45° FOV
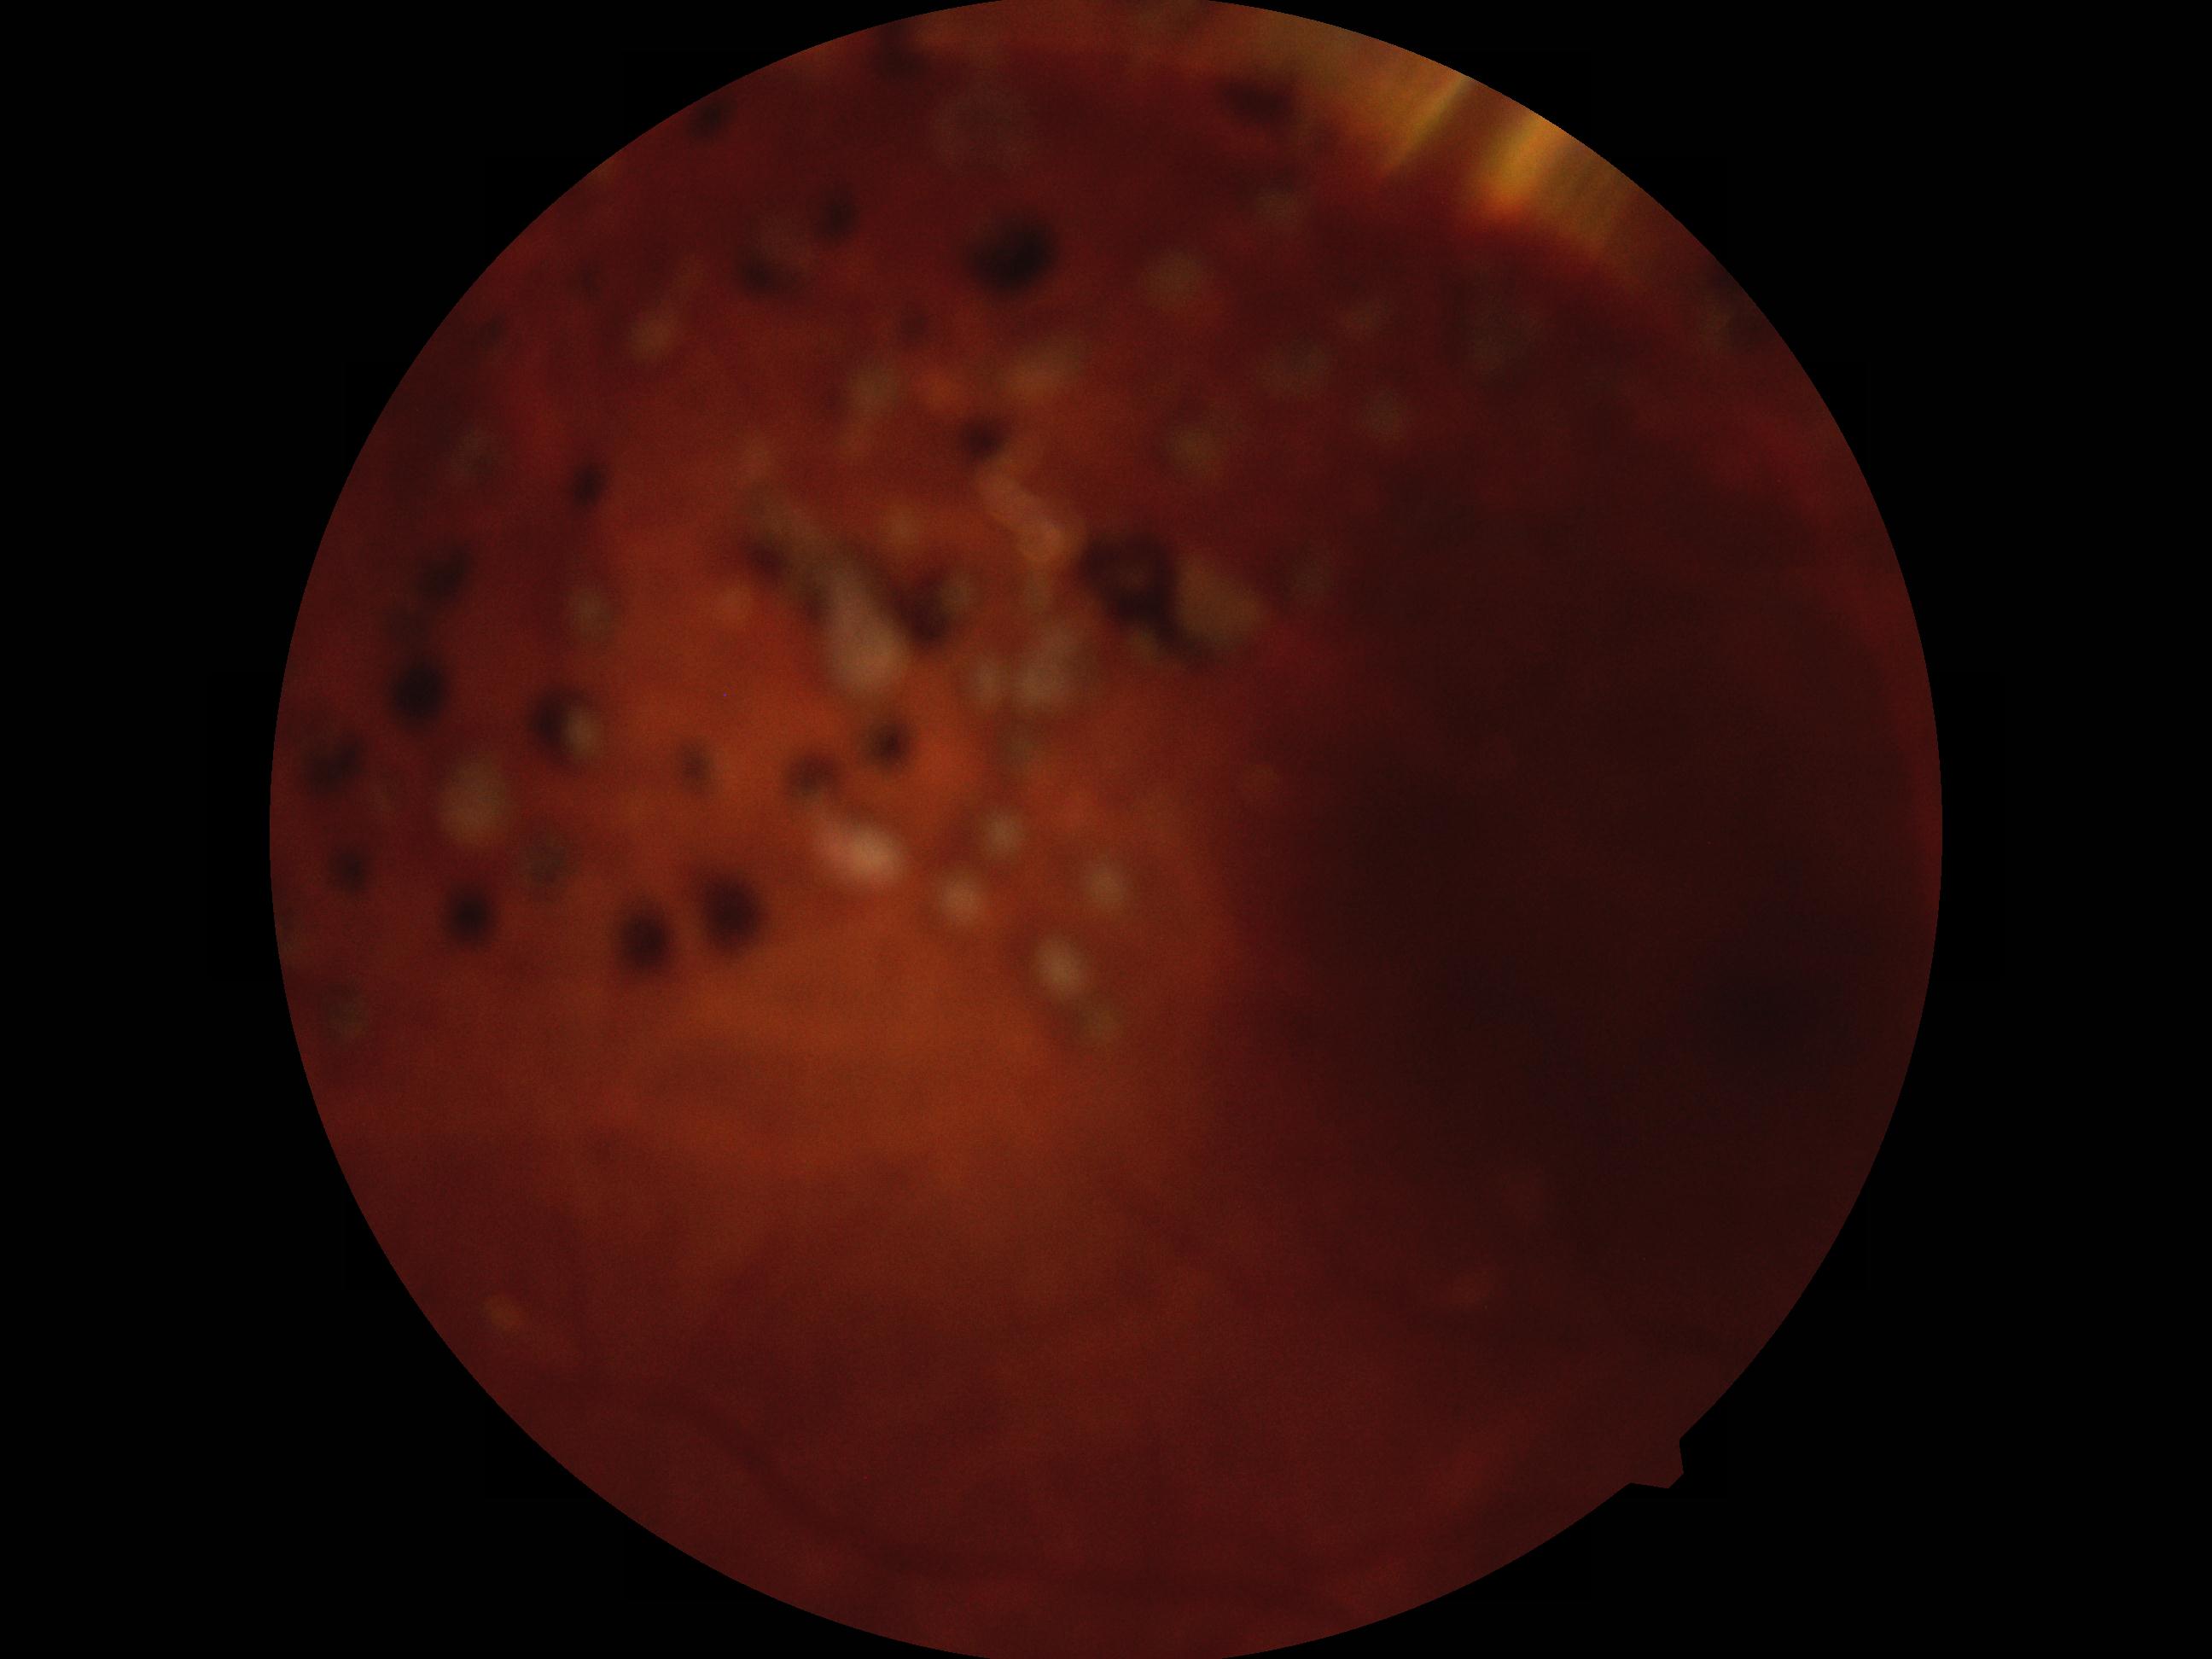

diabetic retinopathy severity: no apparent diabetic retinopathy (grade 0).